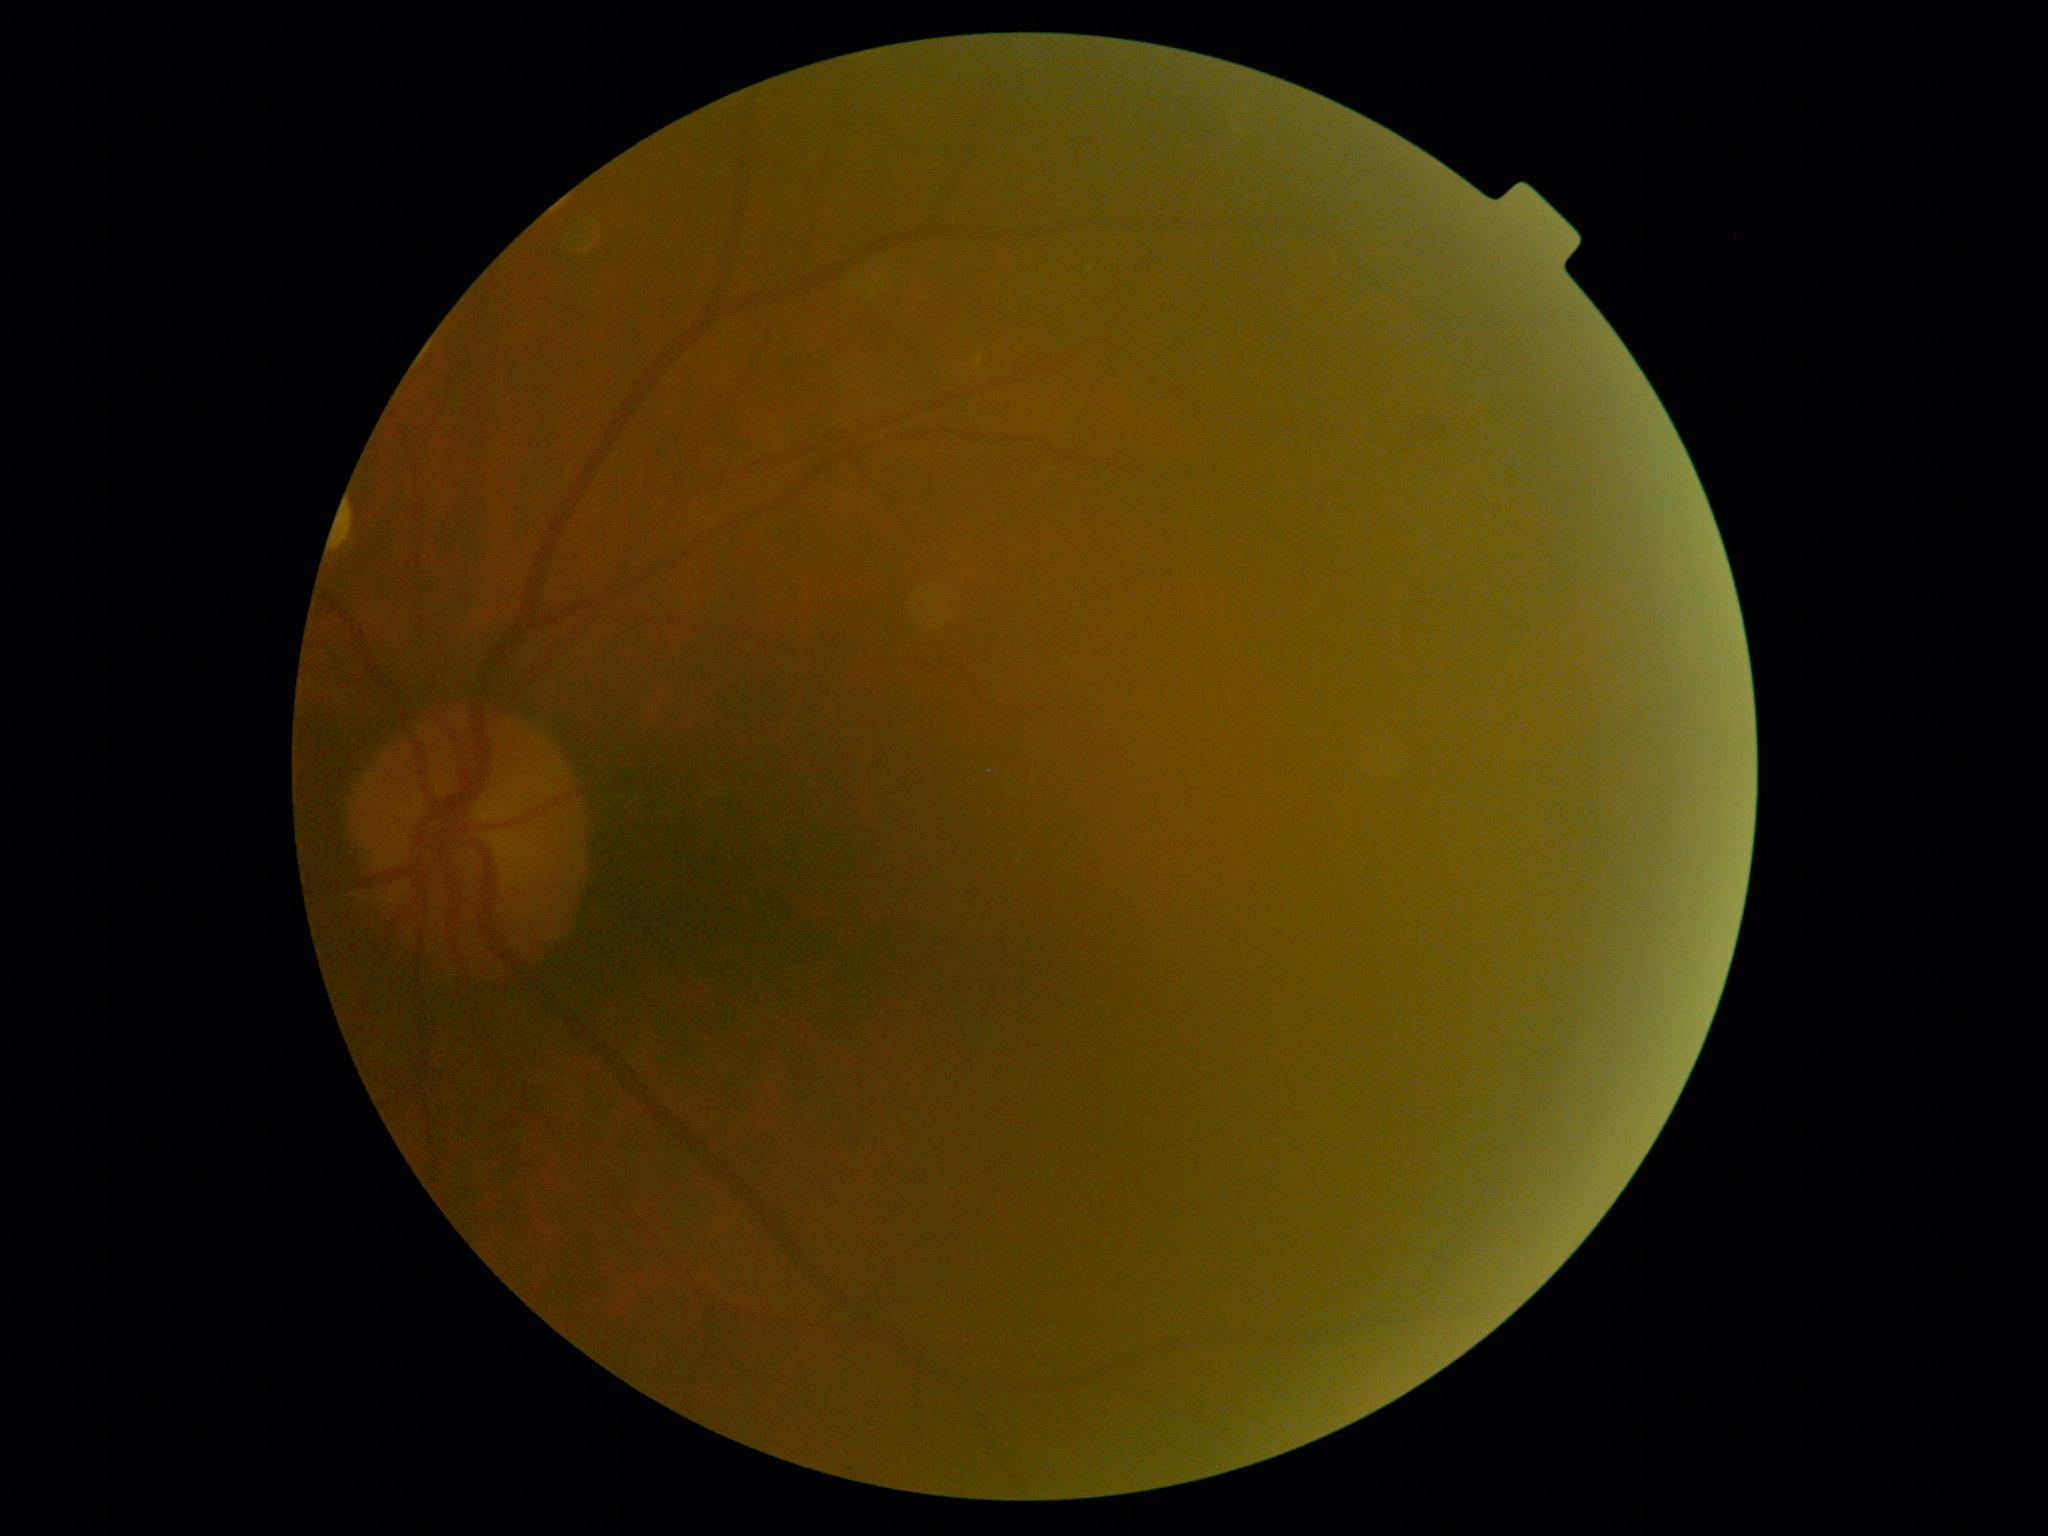

Retinopathy: moderate NPDR (grade 2).